Davis DR grading · NIDEK AFC-230 fundus camera: 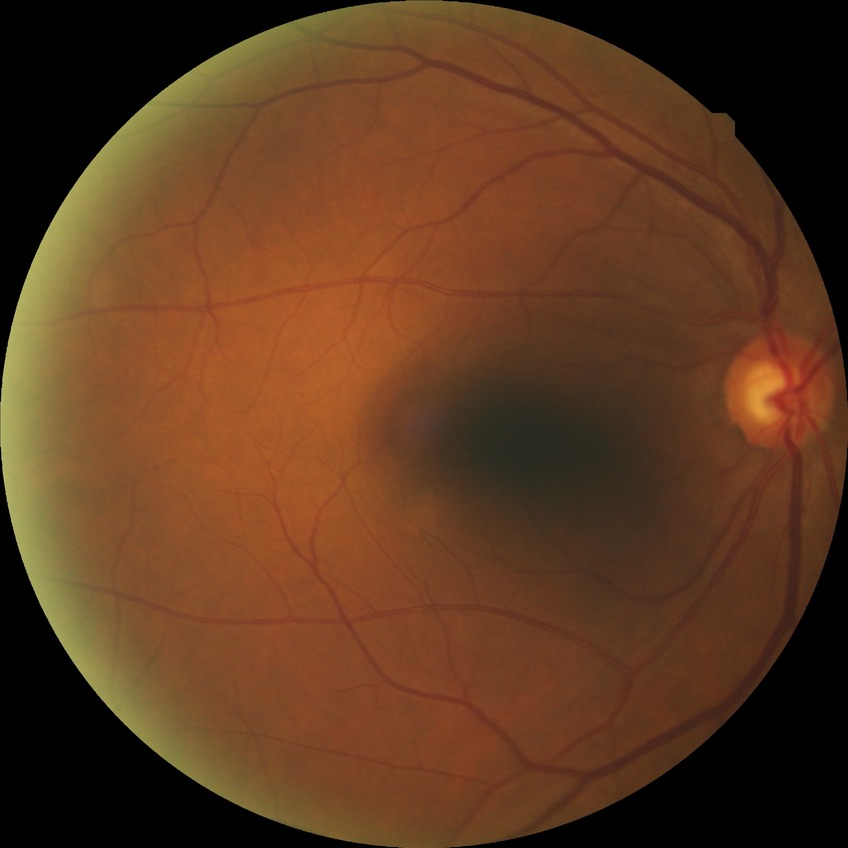
{"proliferative_class": "non-proliferative diabetic retinopathy", "davis_grade": "SDR (simple diabetic retinopathy)"}